DR severity per modified Davis staging. 45-degree field of view — 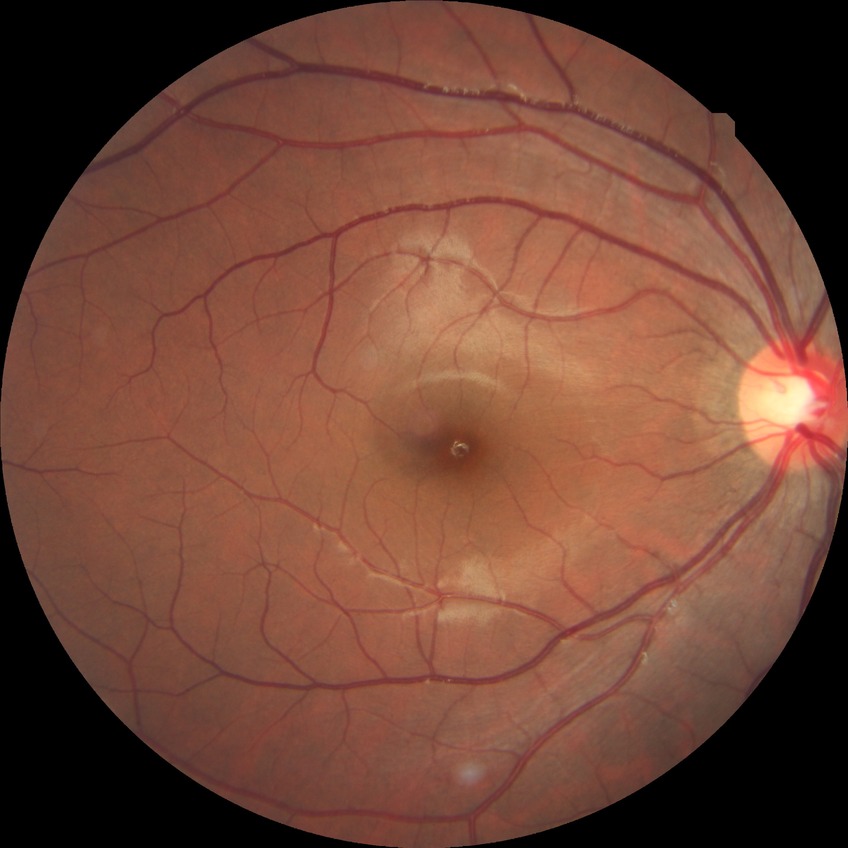

– diabetic retinopathy (DR) — NDR (no diabetic retinopathy)